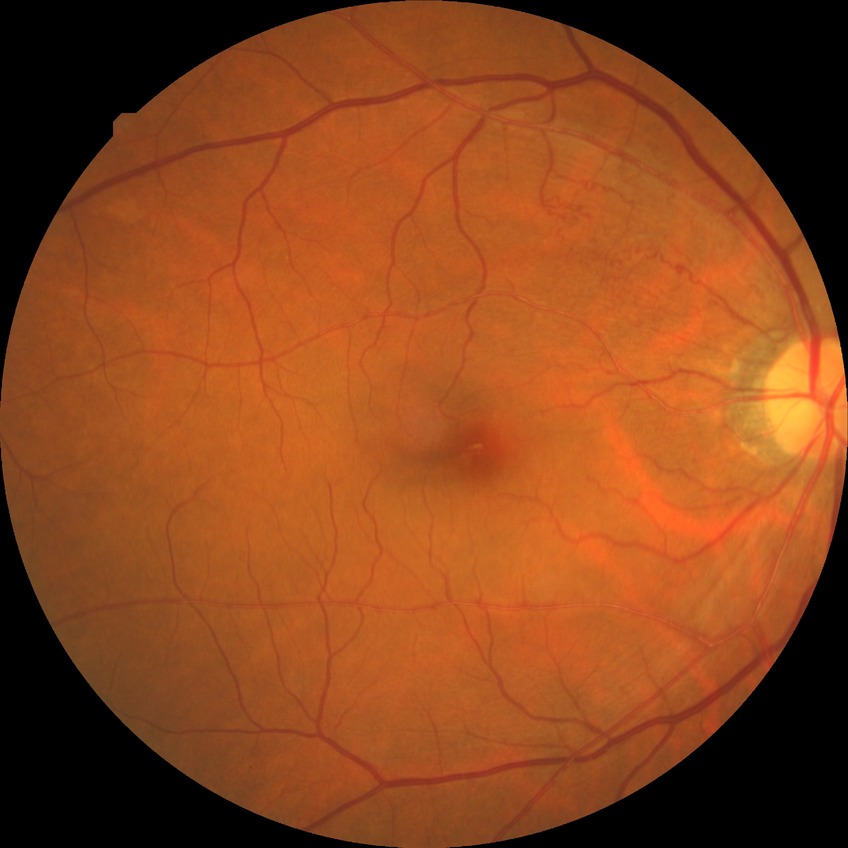 modified Davis grade@NDR.